45° field of view: 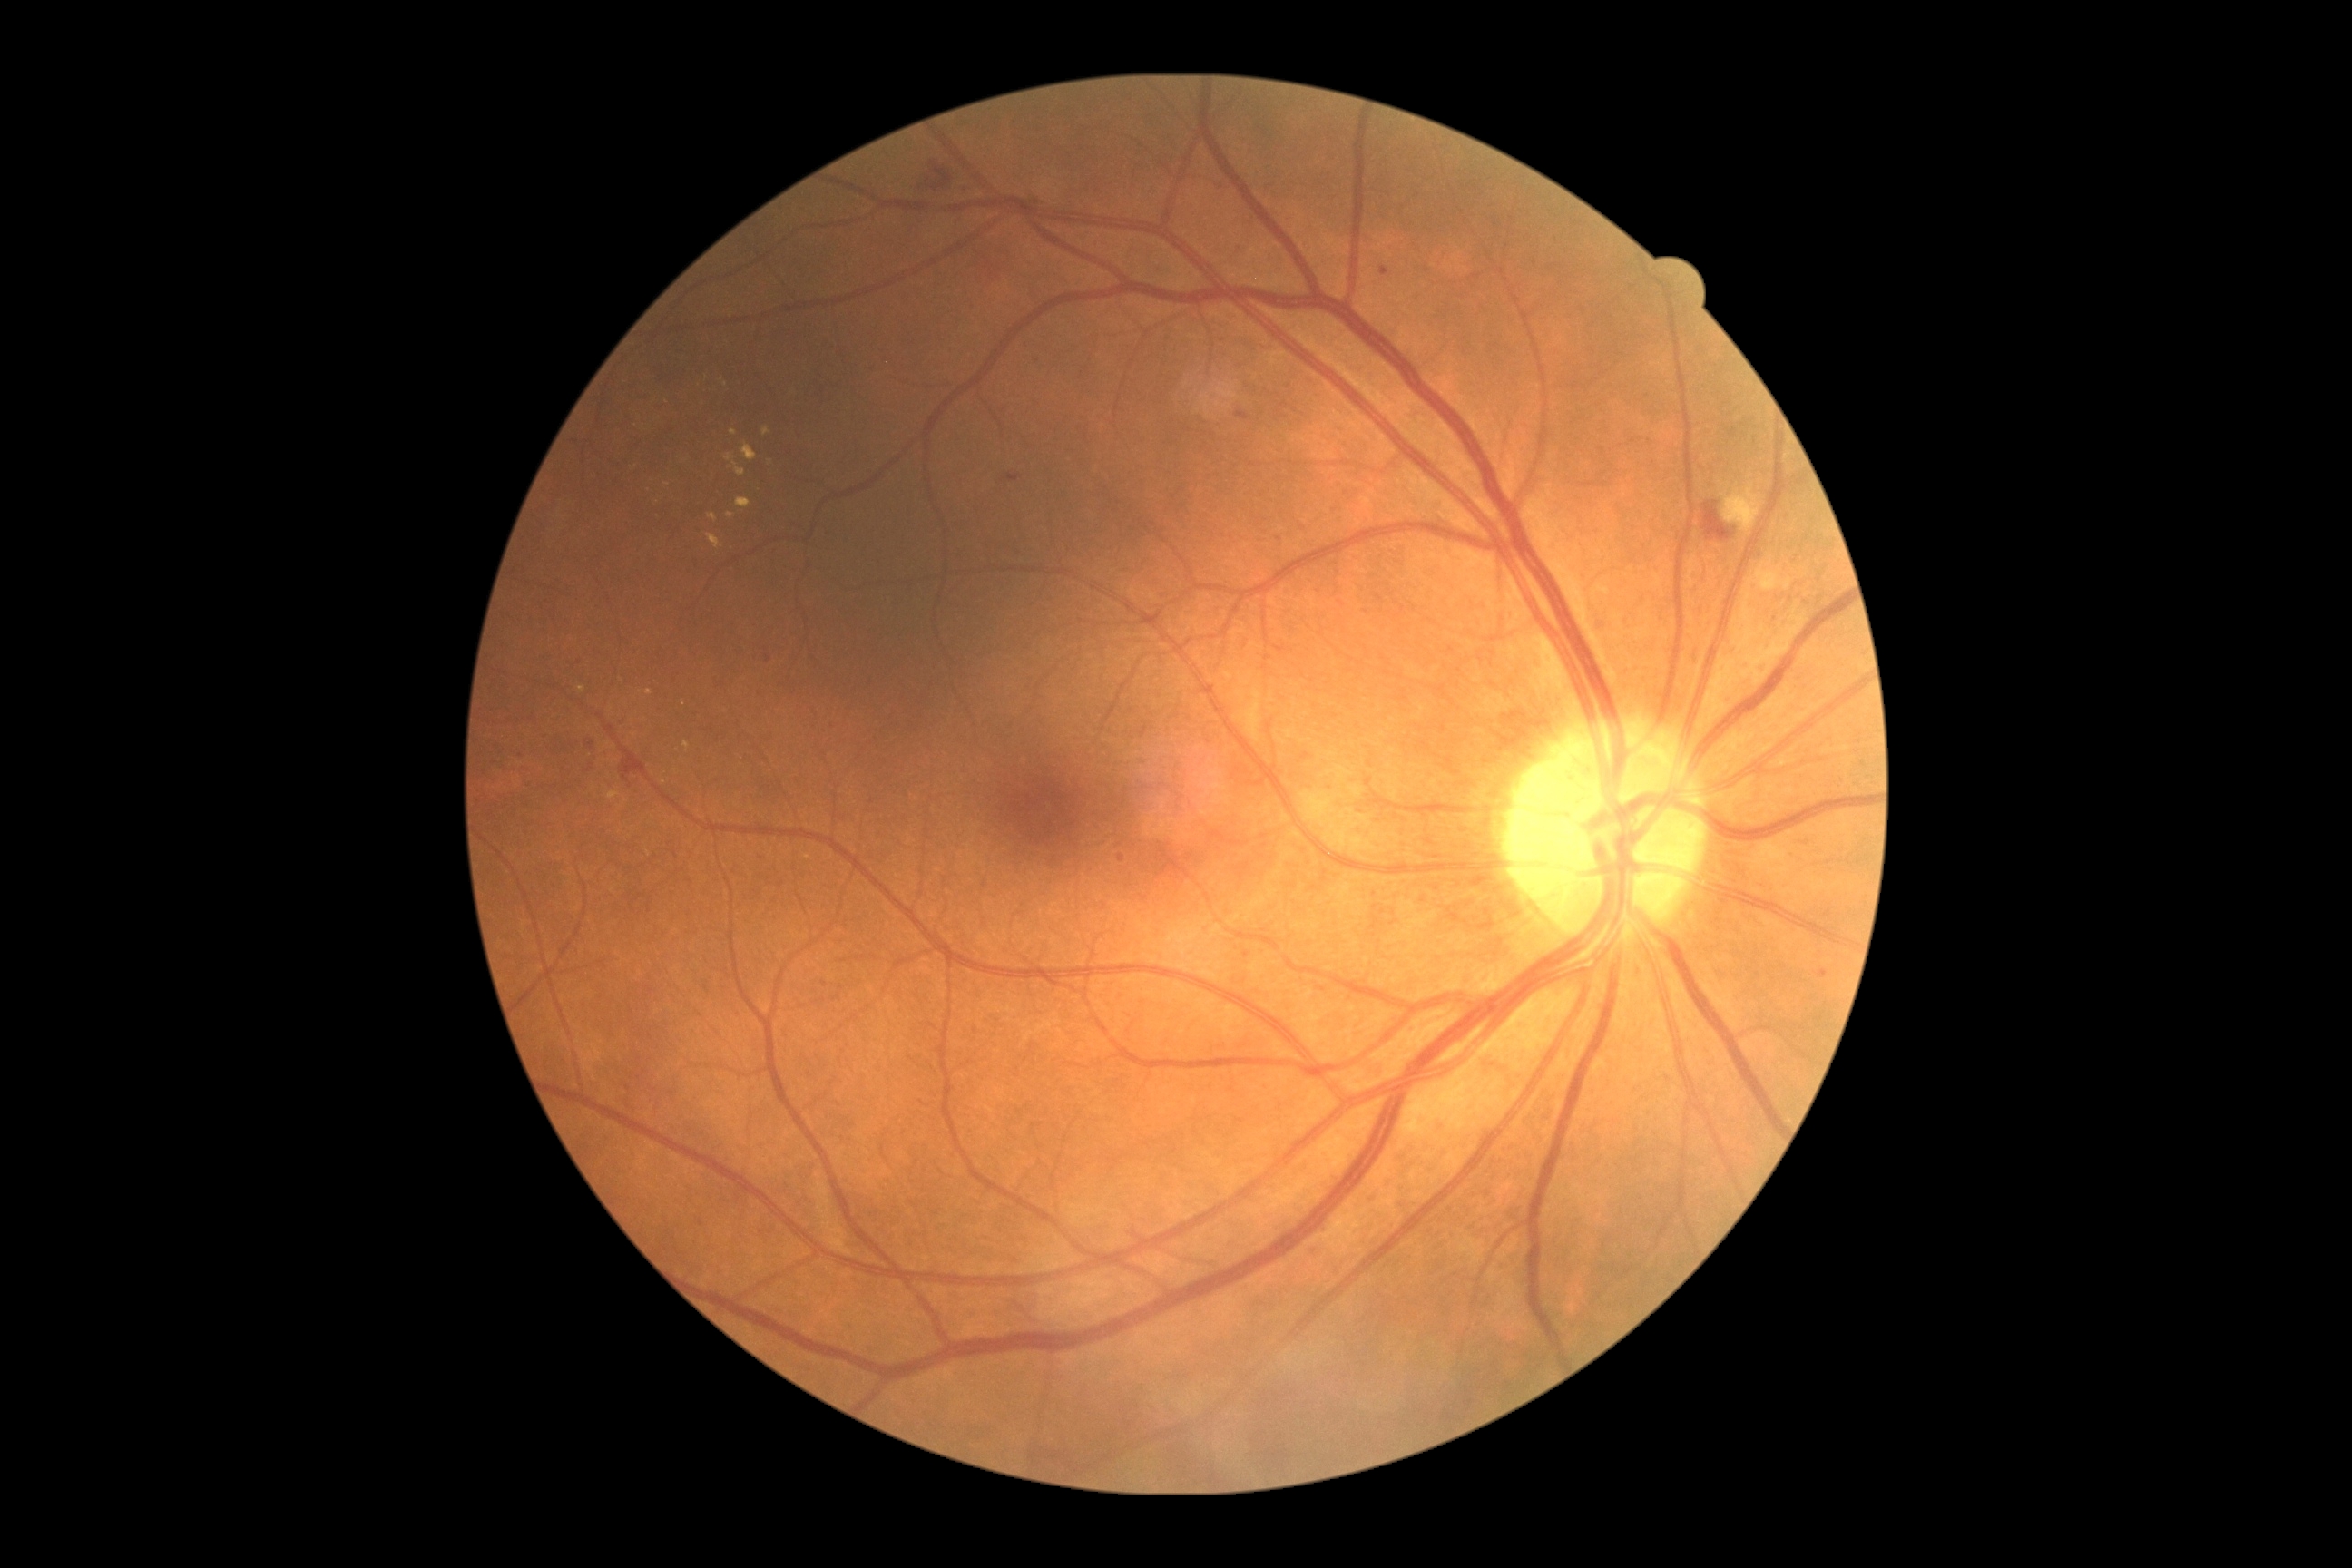

DR severity@2/4.